45° FOV · 2352x1568 · retinal fundus photograph: 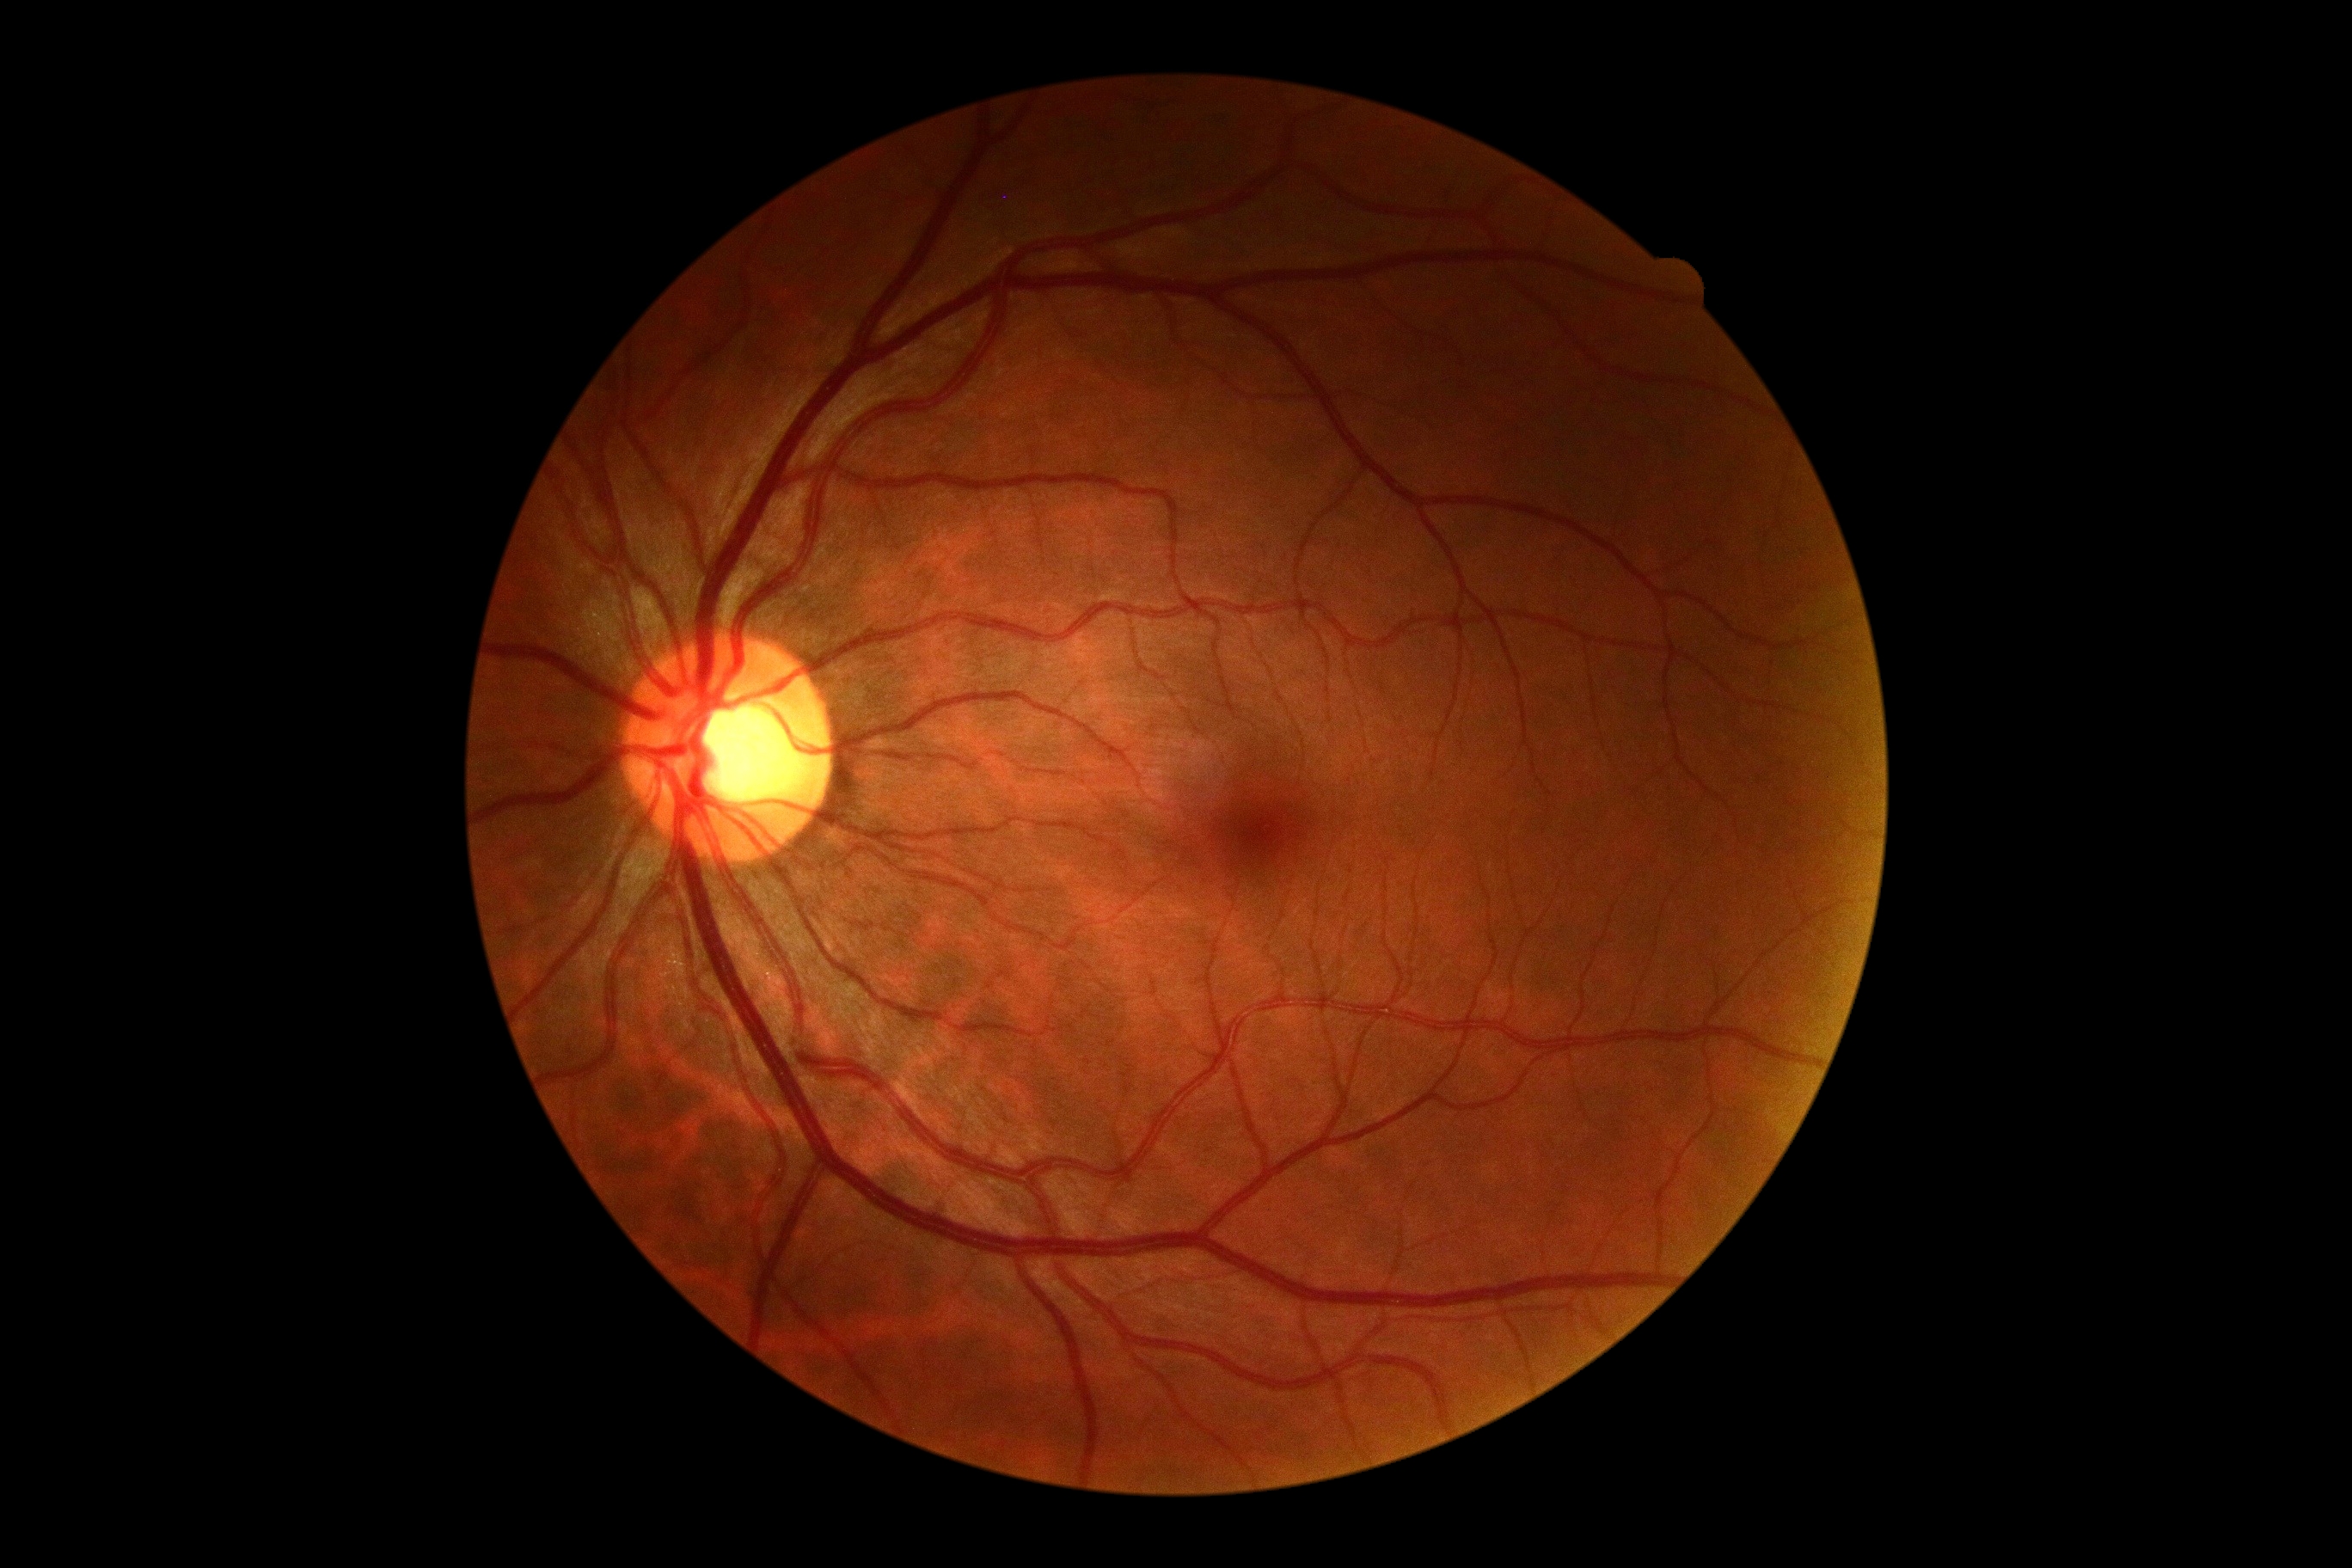 Annotations:
– diabetic retinopathy grade: no apparent retinopathy (0) — no visible signs of diabetic retinopathy